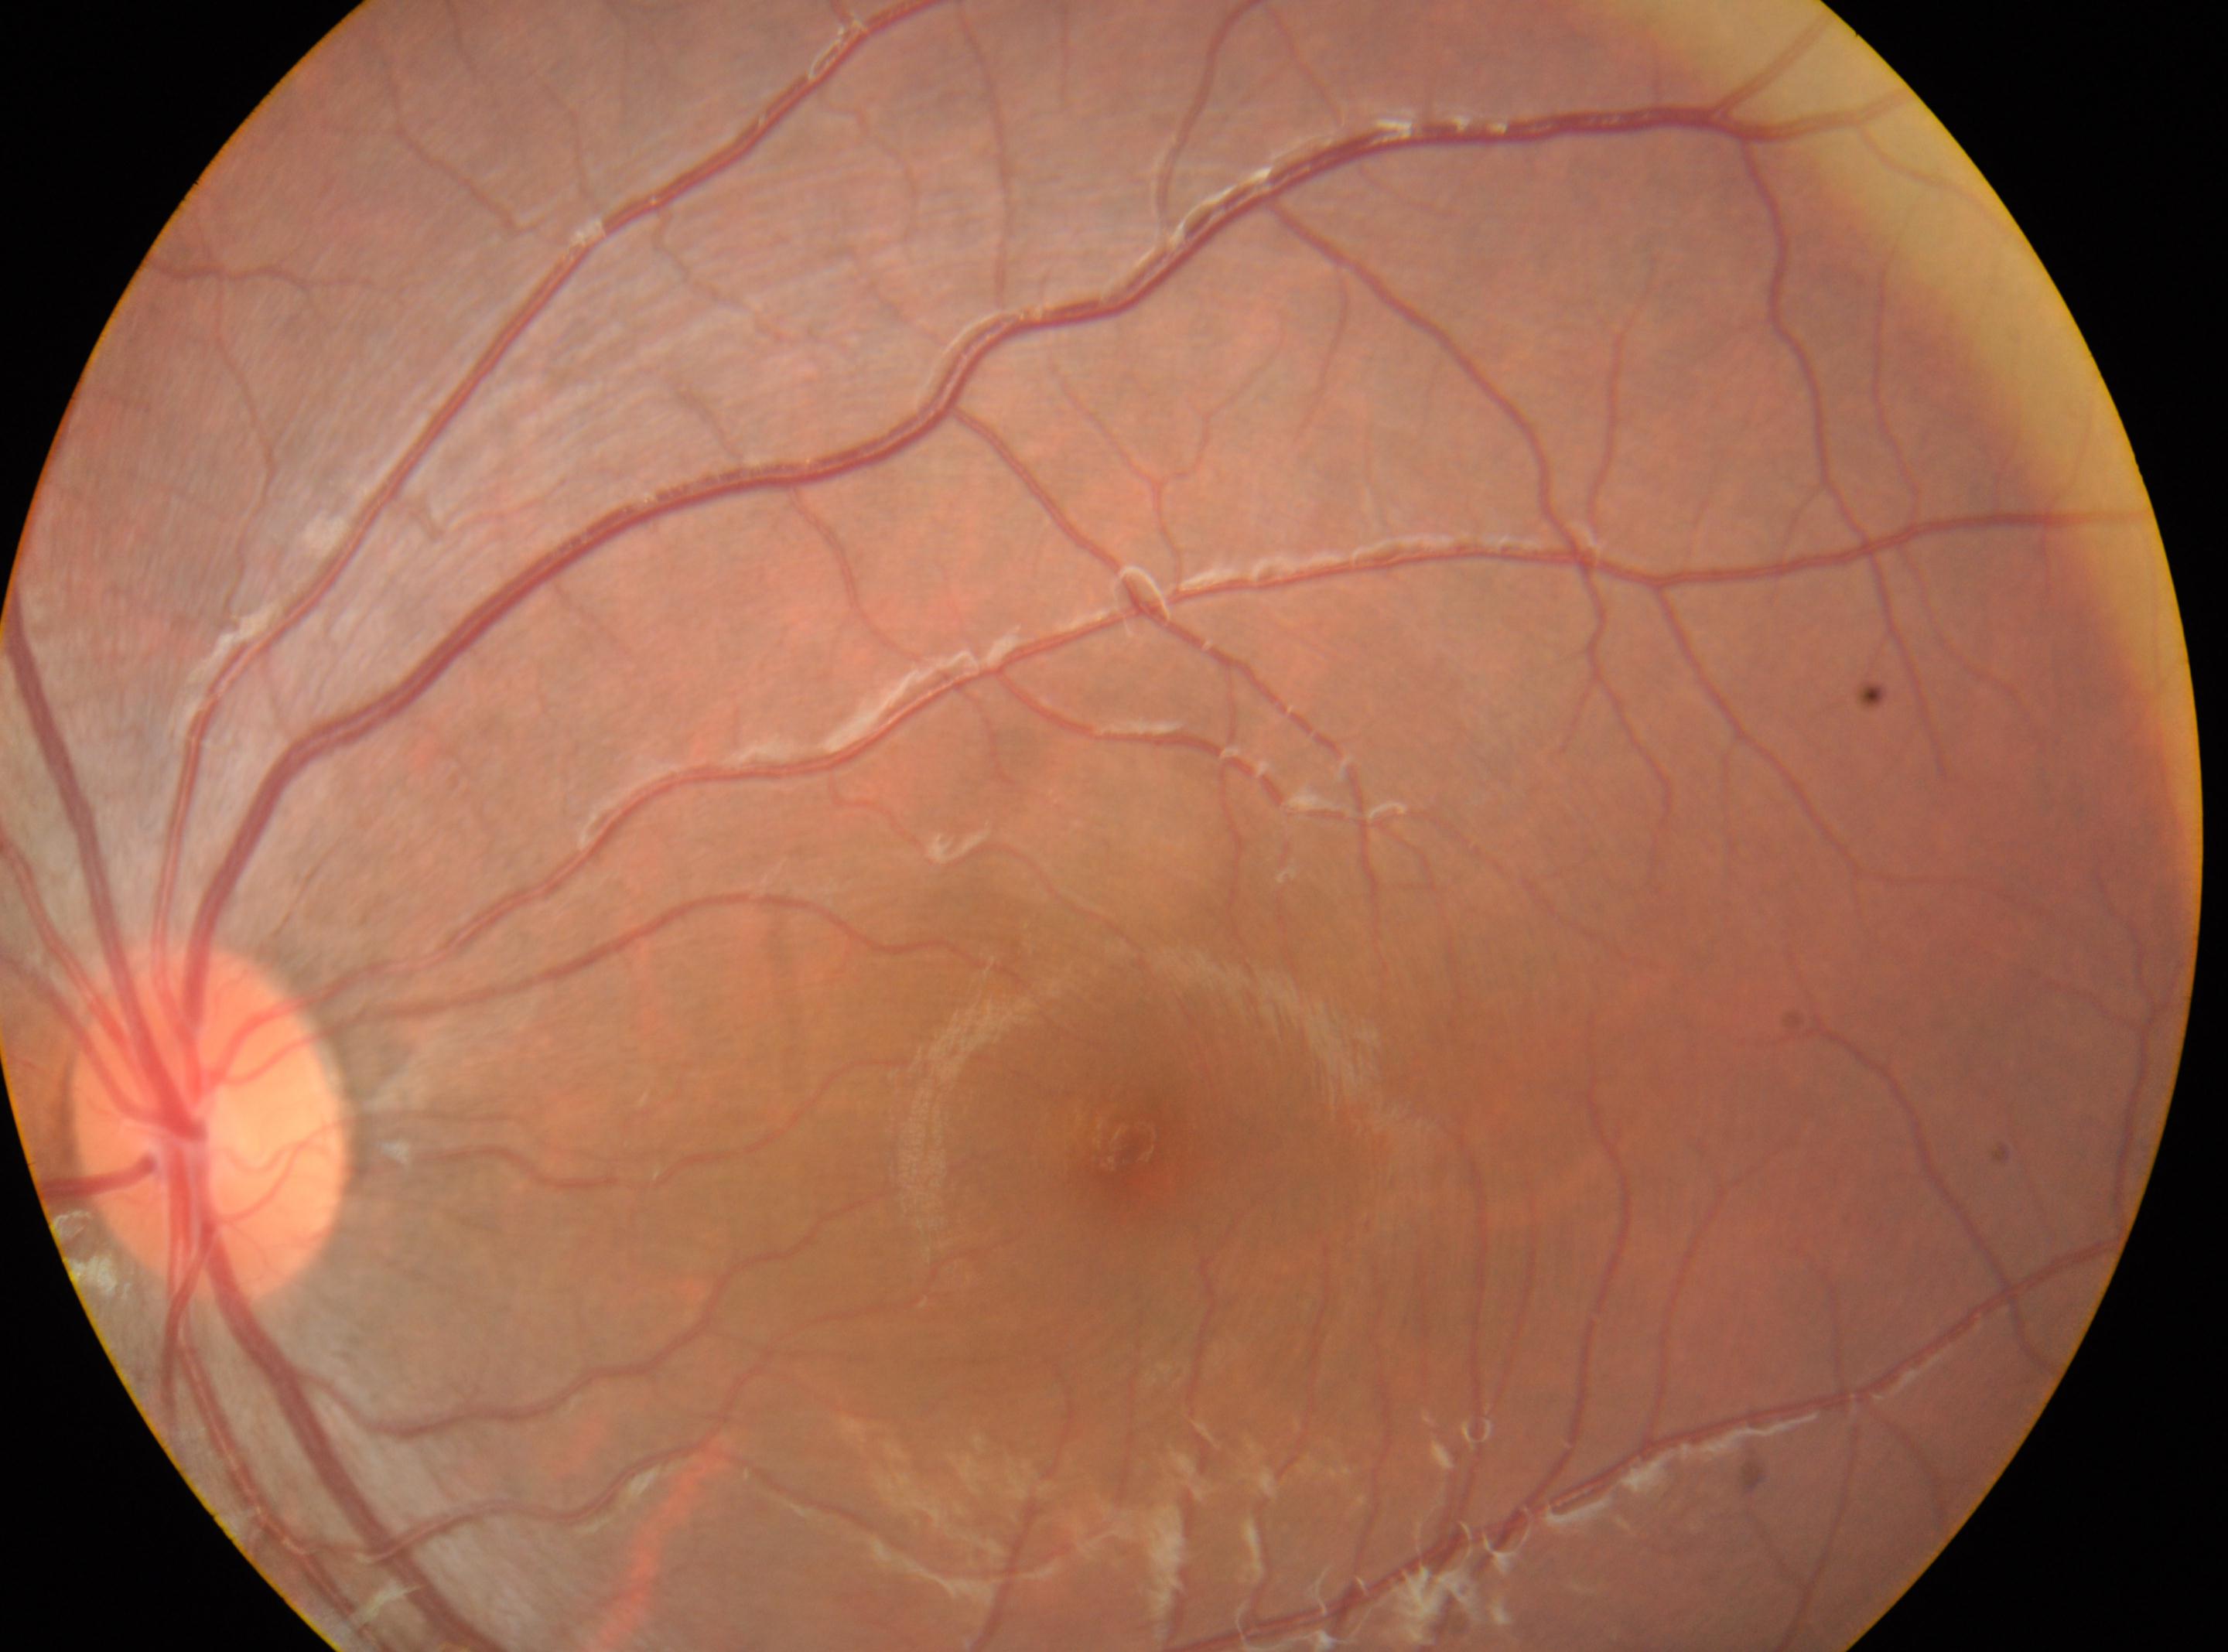 optic disc center: (x=210, y=1123); foveal center: (x=1129, y=1146); diabetic retinopathy: grade 0 (no apparent retinopathy) — no visible signs of diabetic retinopathy; the left eye; No diabetic retinopathy identified.